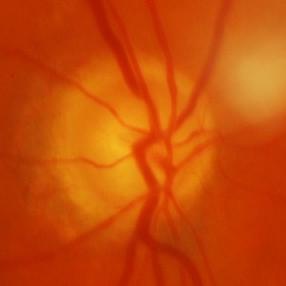

Glaucomatous optic neuropathy is present. Demonstrates glaucomatous changes.